Infant wide-field fundus photograph · 1440 by 1080 pixels
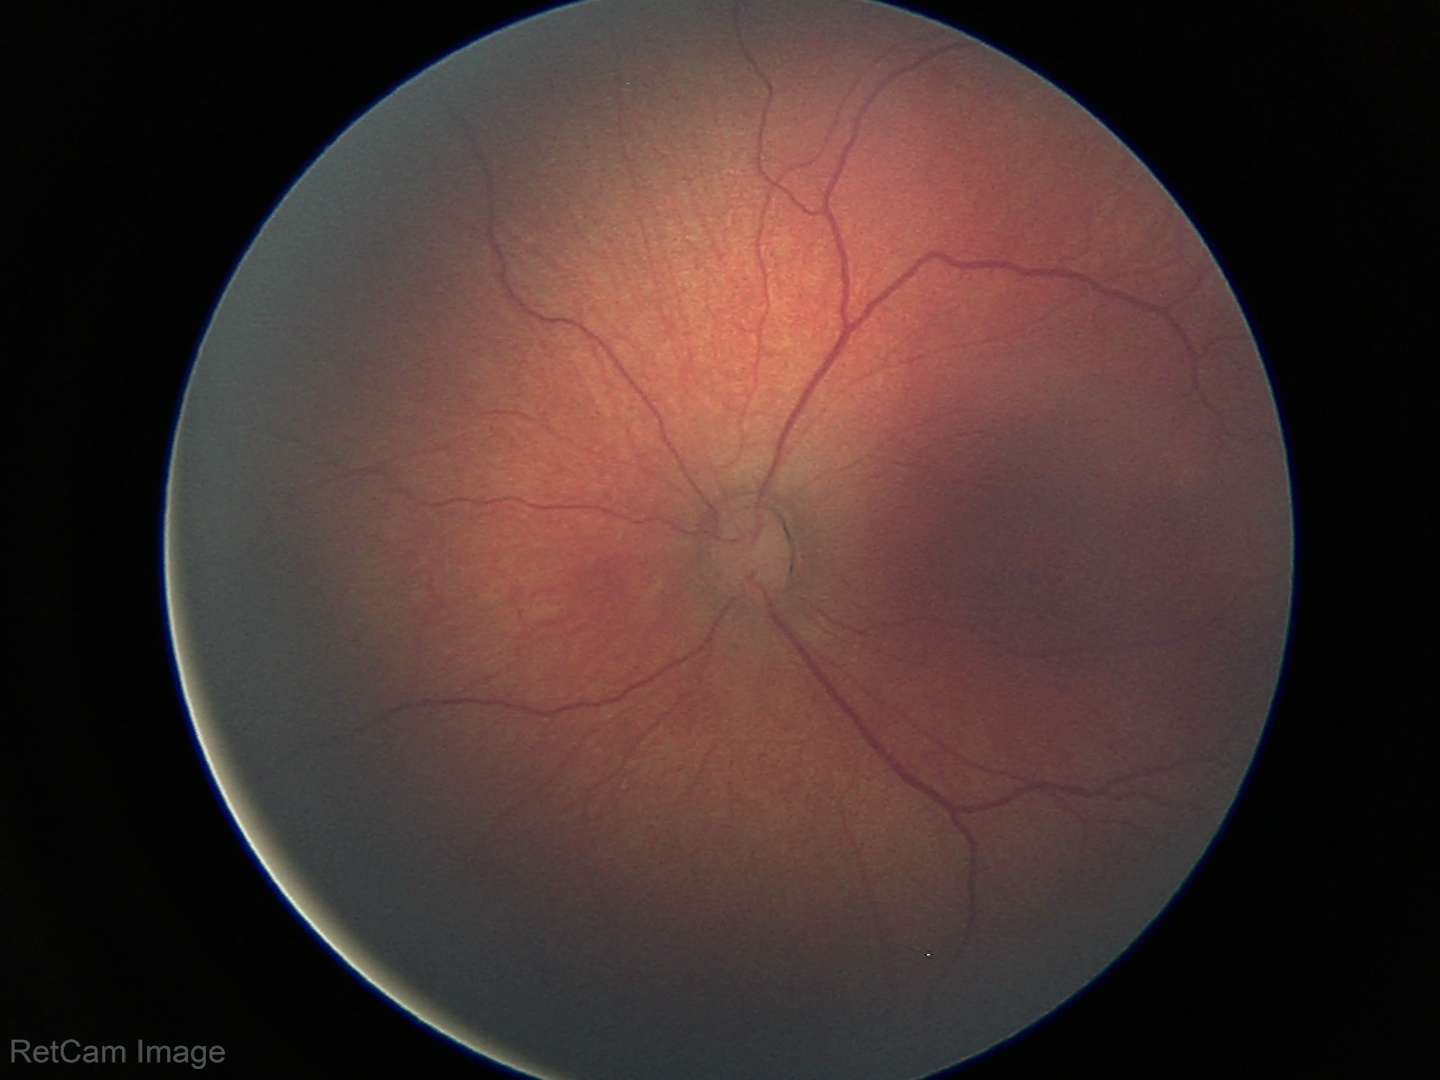

Series diagnosed as retinopathy of prematurity (ROP) stage 2.
No plus disease.